2048x1536px; retinal fundus photograph; 45-degree field of view.
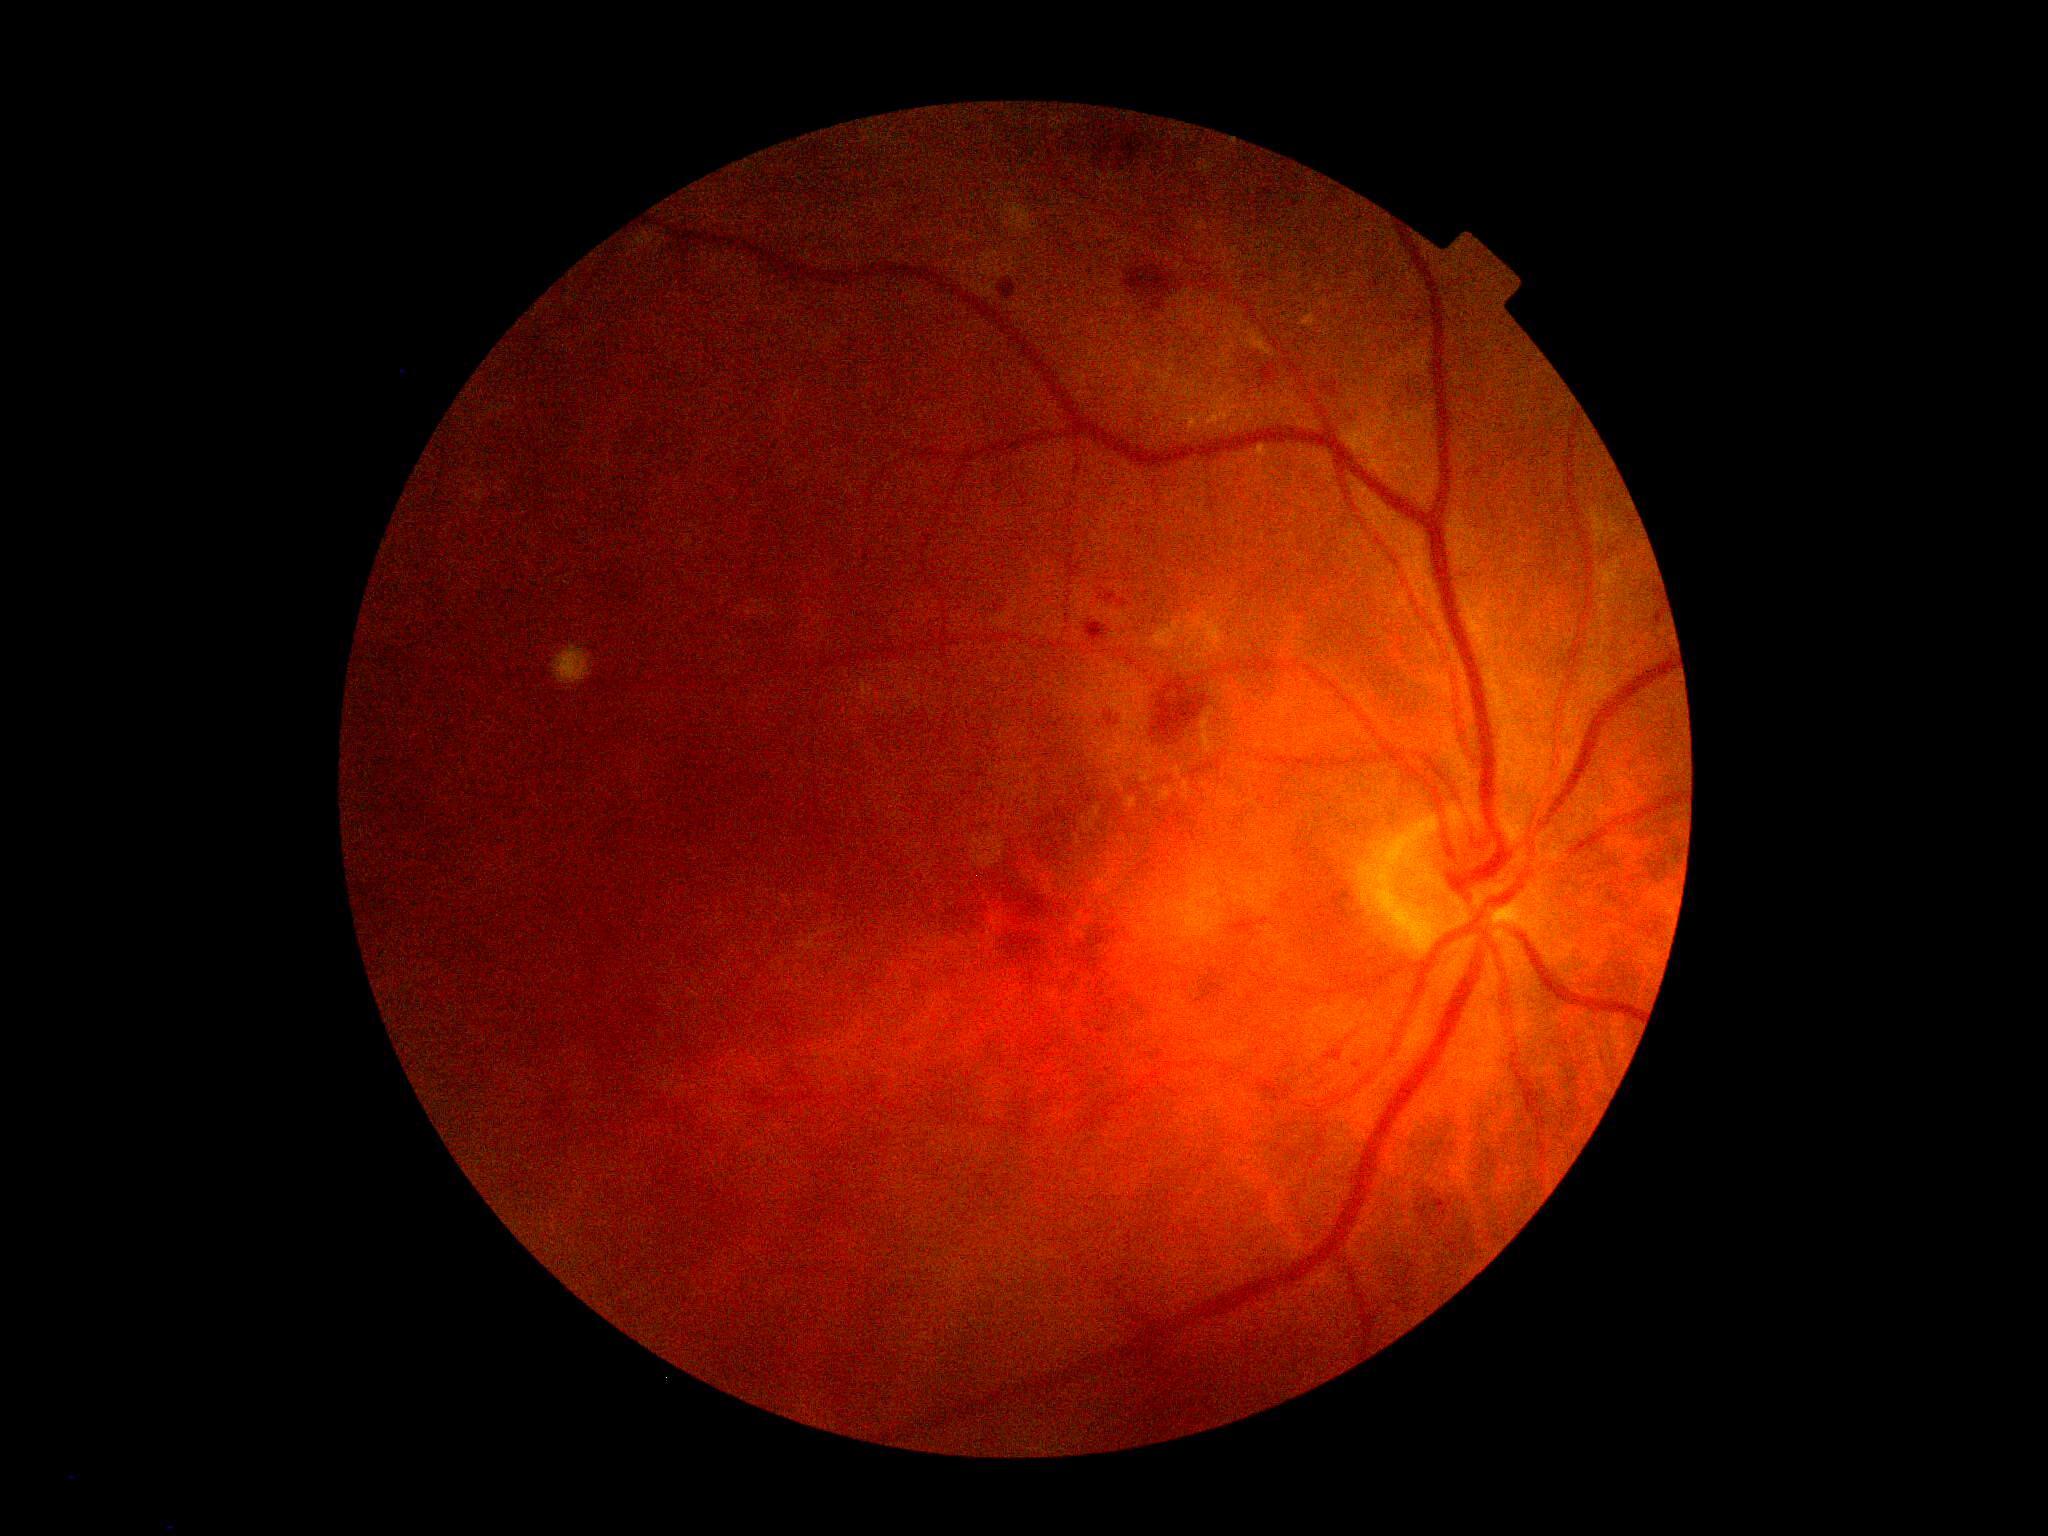

  dr_grade: 2